Color fundus photograph; 2352 x 1568 pixels: 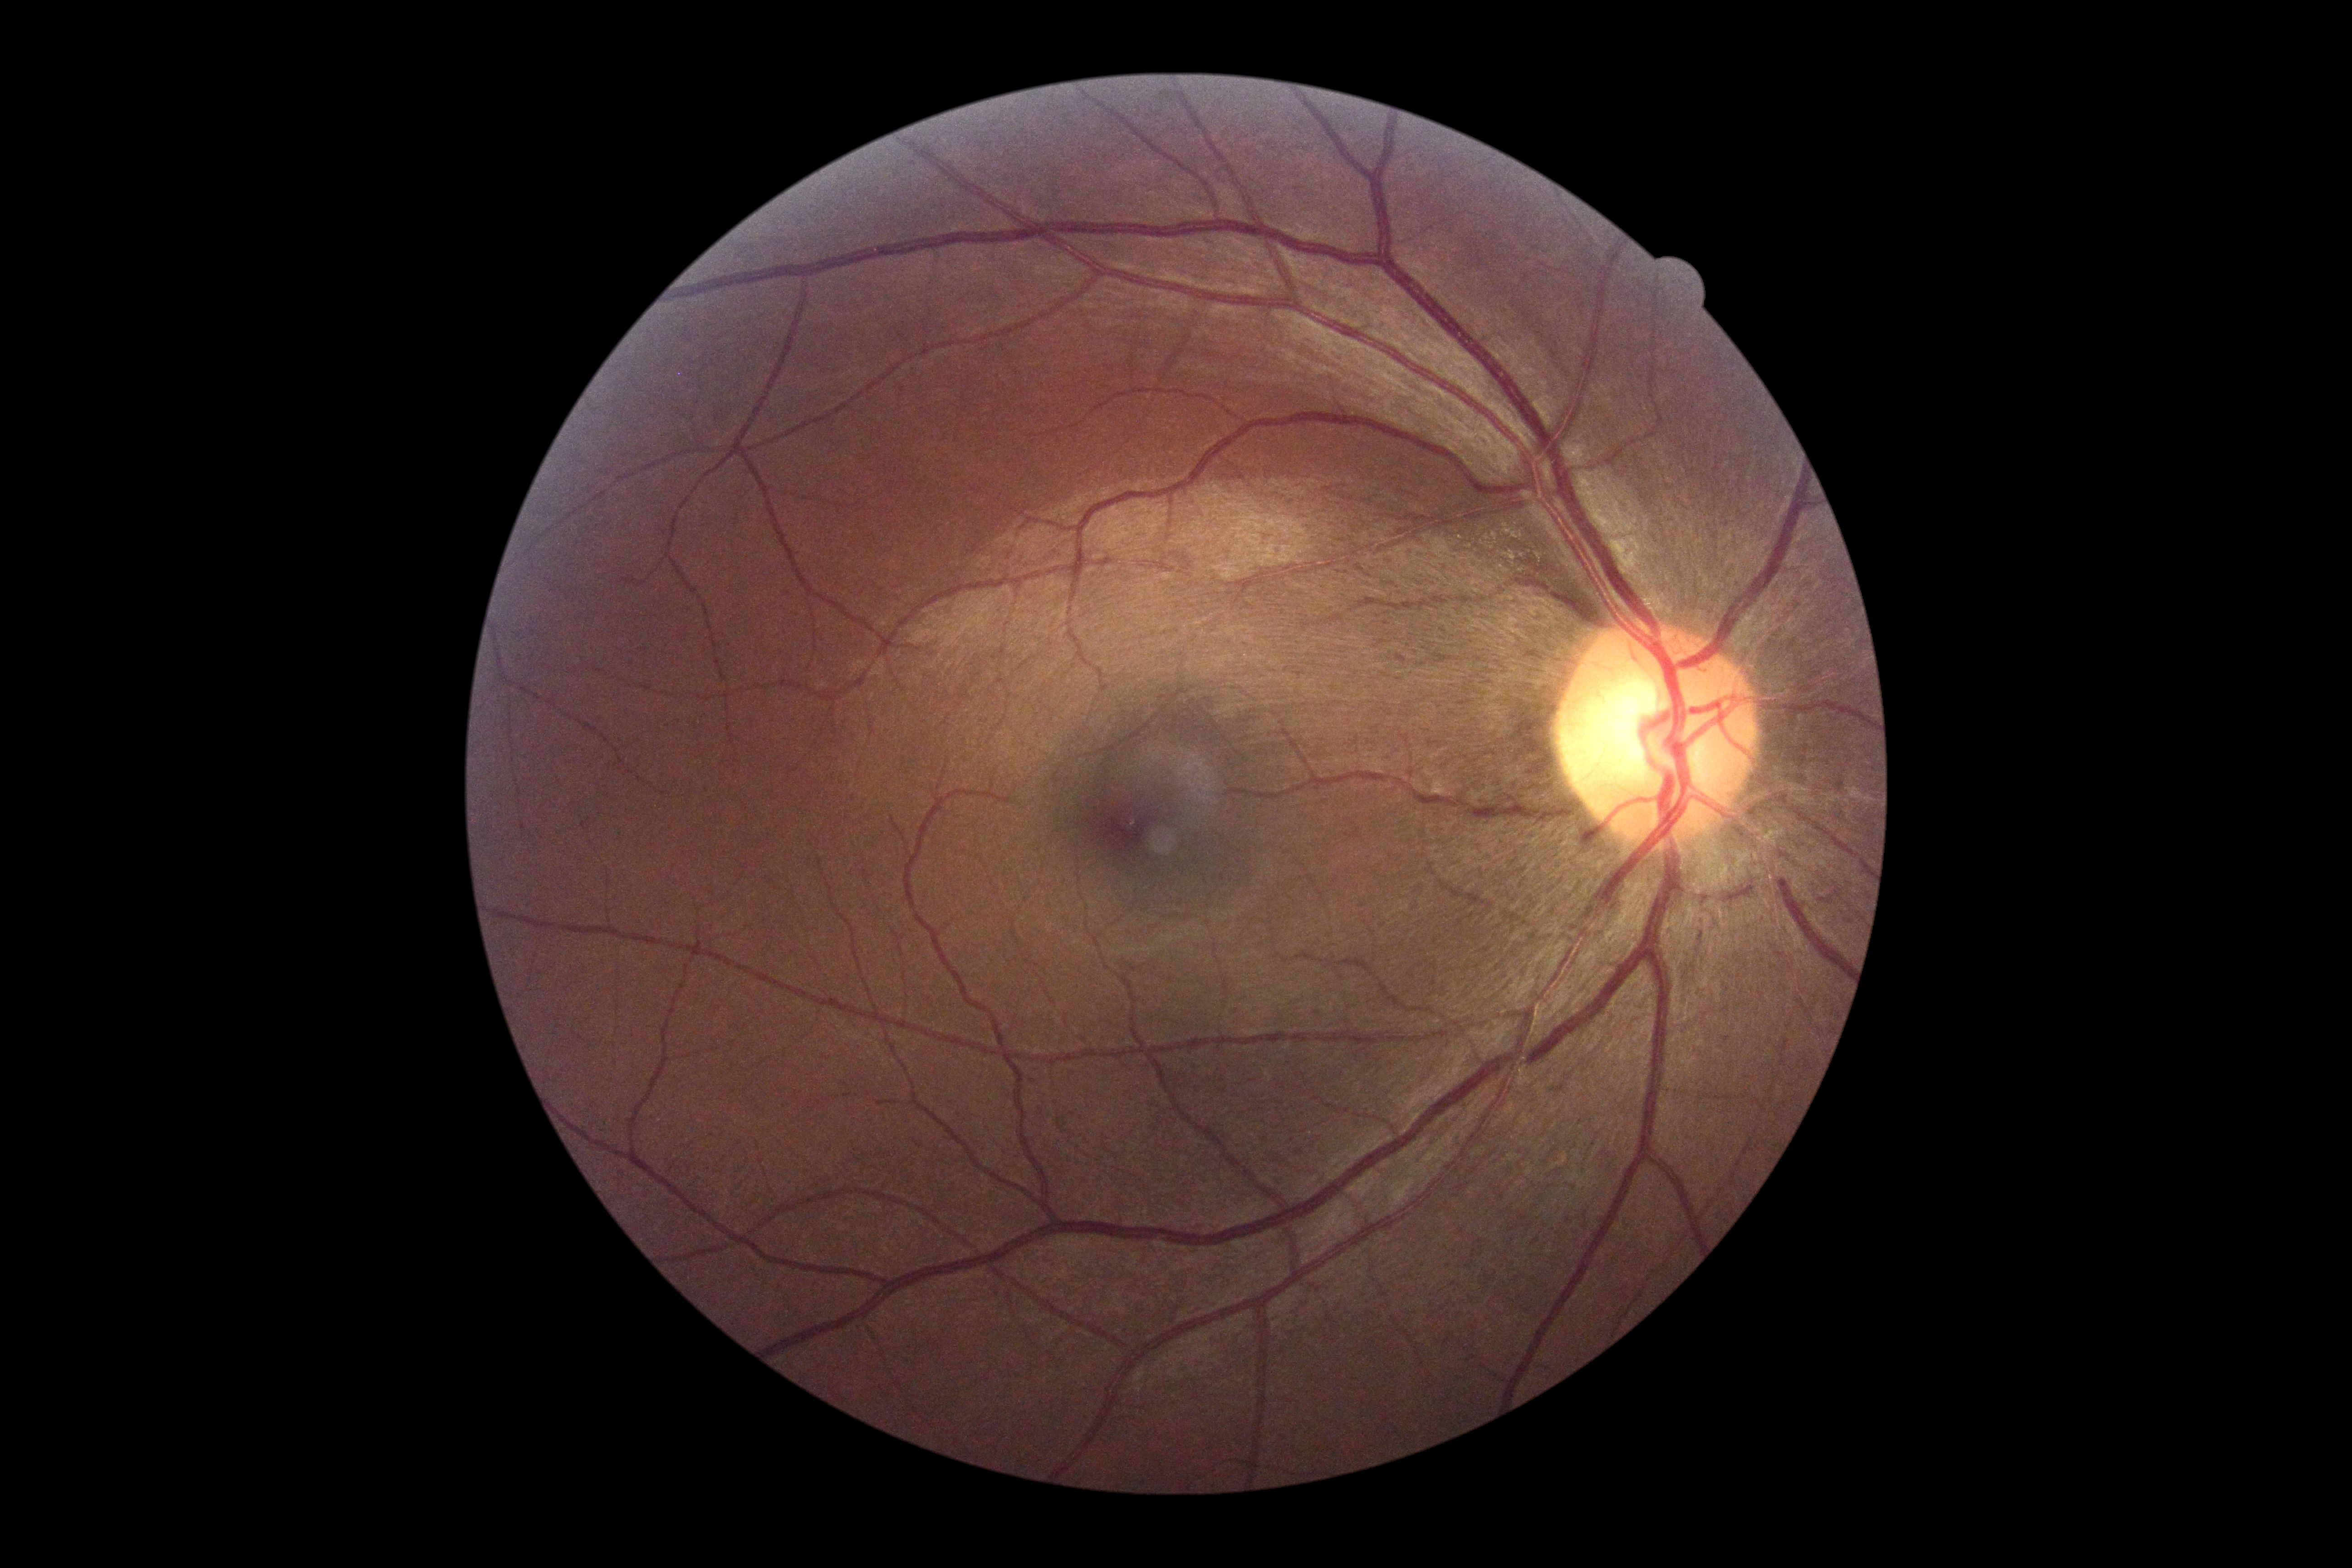
DR impression: no DR findings; diabetic retinopathy: grade 0.